Kowa VX-10α: 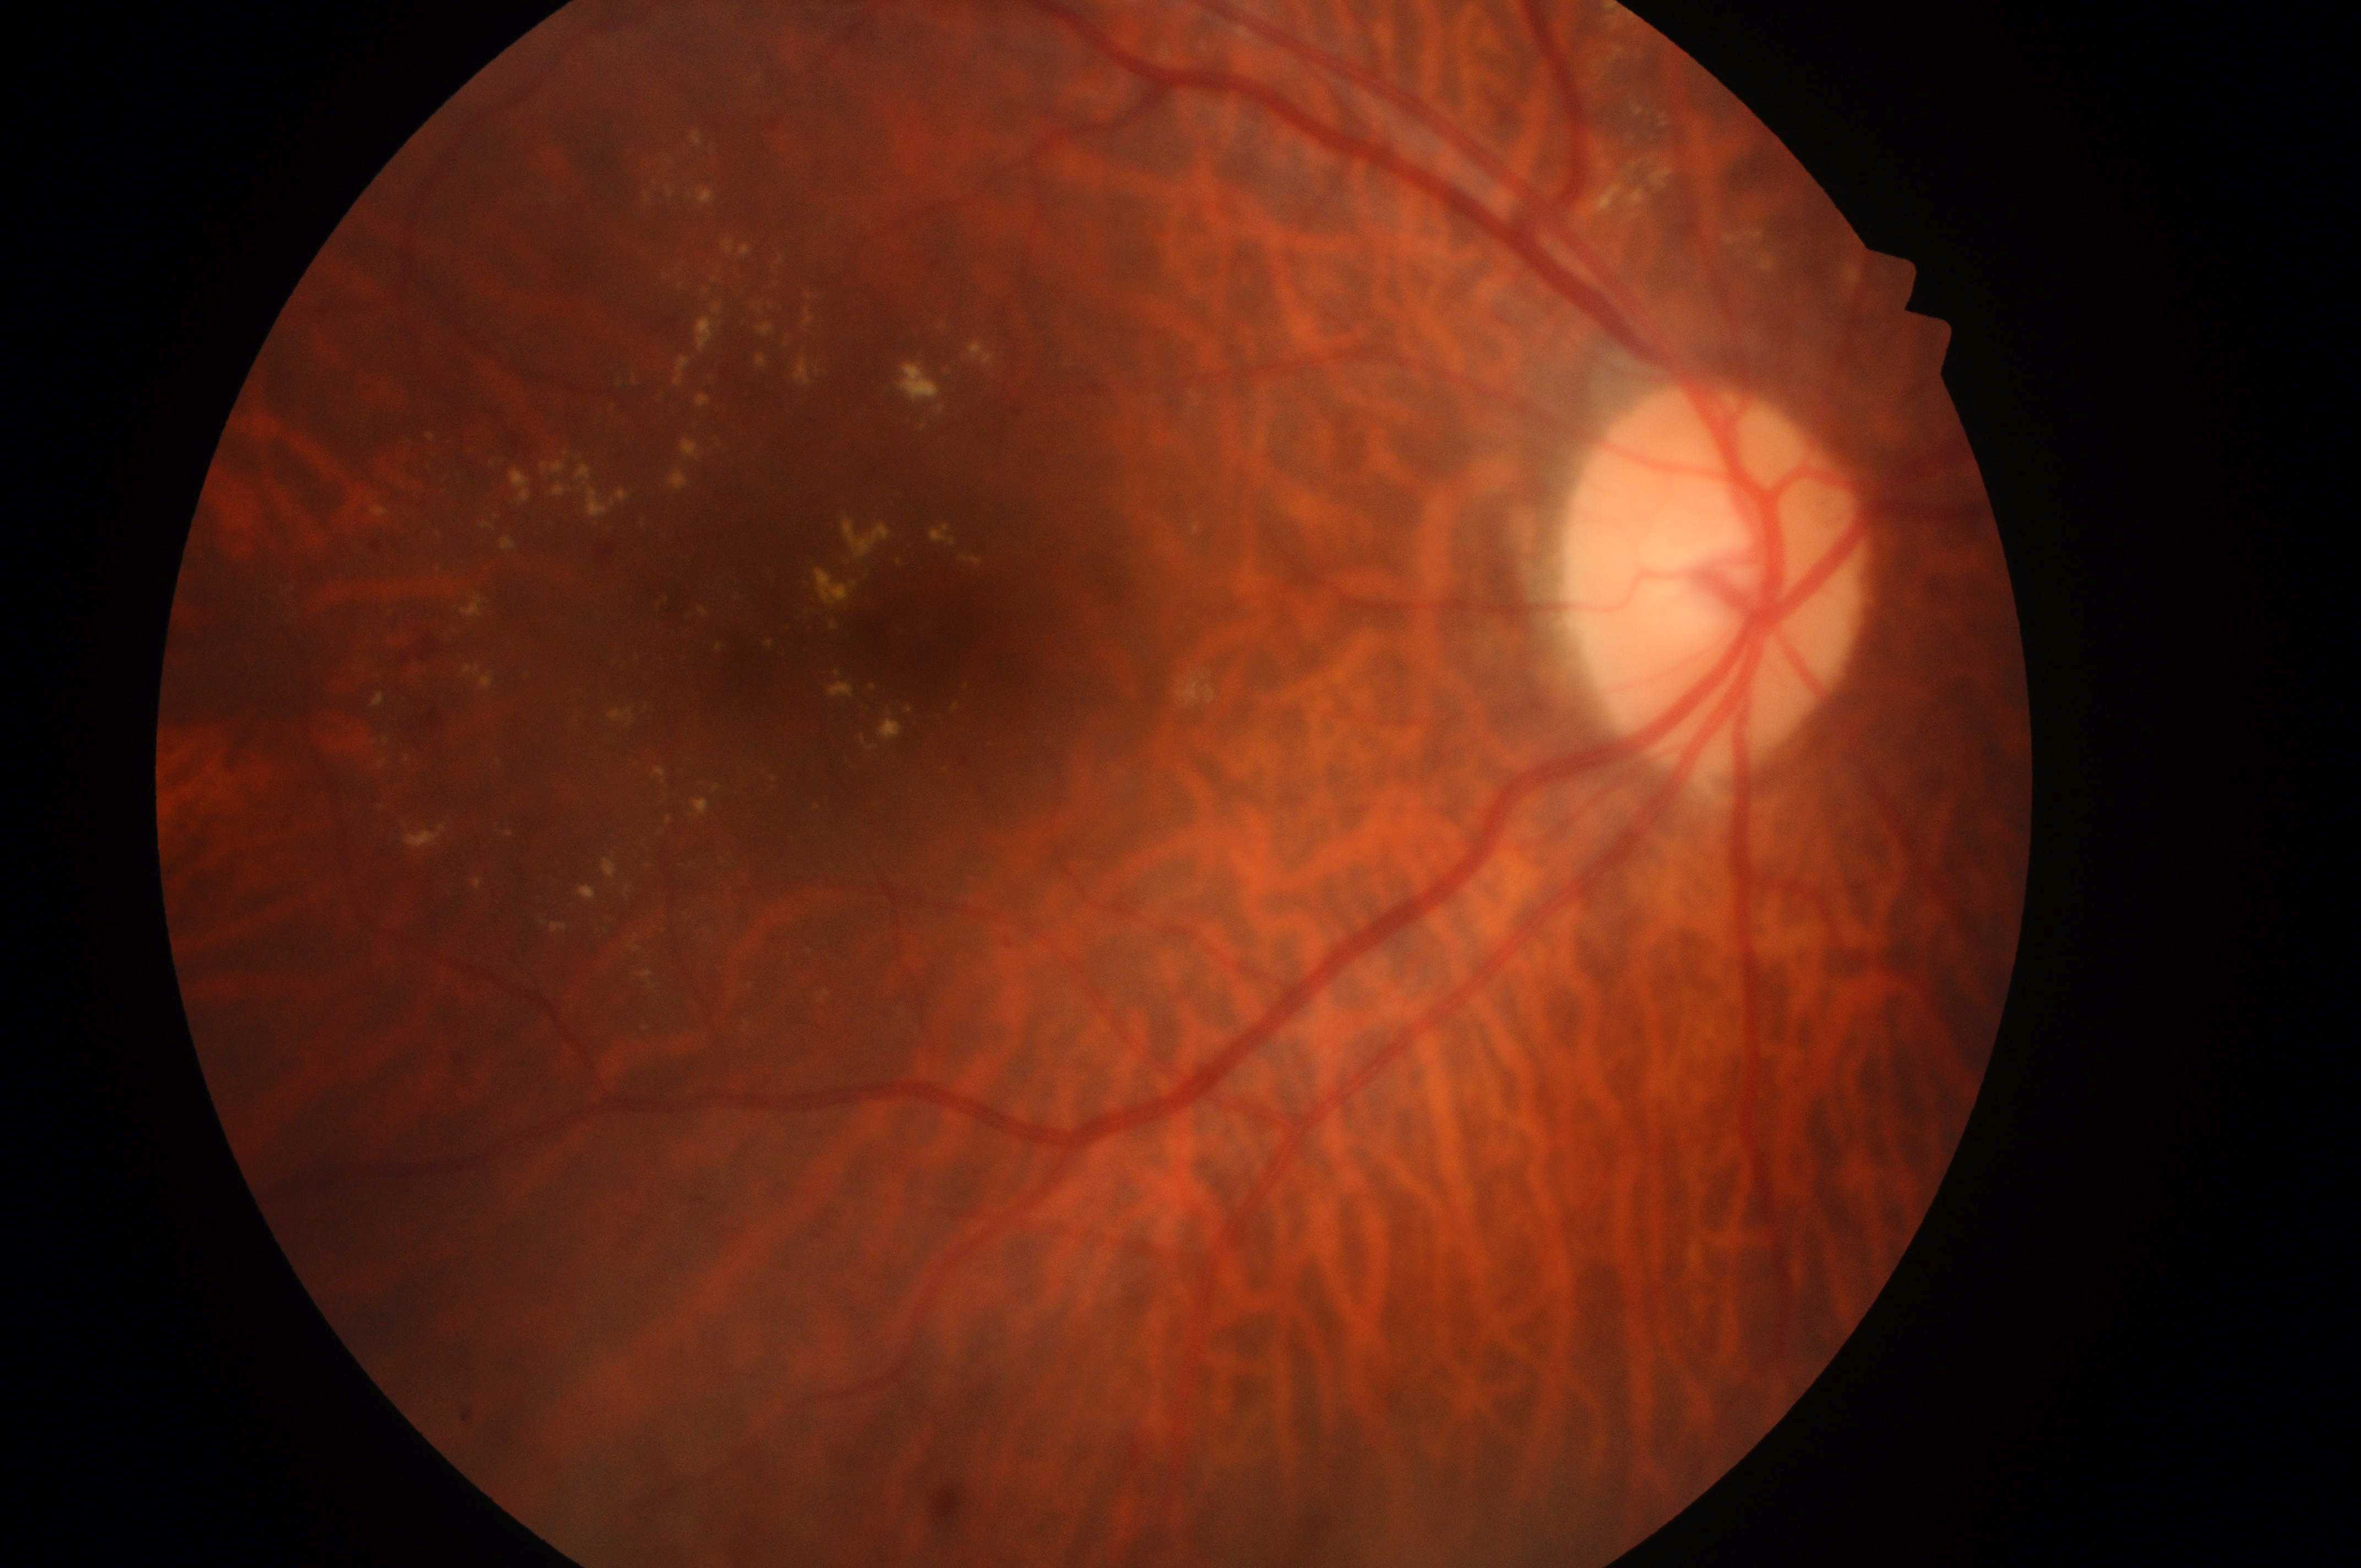
* DR class: non-proliferative diabetic retinopathy
* macula center: (918,639)
* DME grade: 2
* DR: 2/4
* the optic disc: (1714,587)
* laterality: the right eye